Wide-field fundus image from infant ROP screening. Image size 640x480: 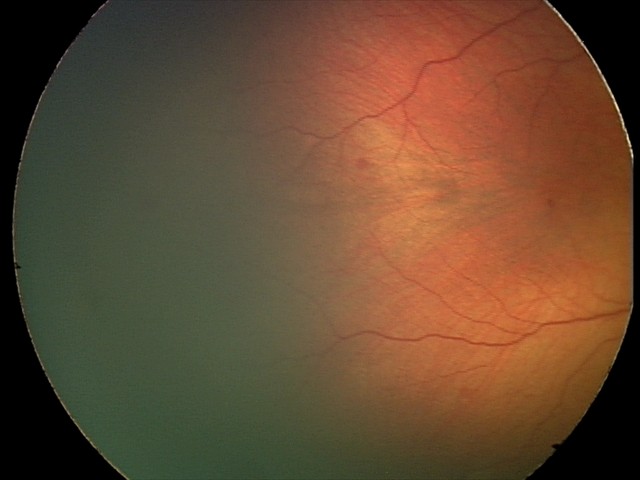

Diagnosis = normal retinal appearance.